Color fundus photograph. 45° FOV
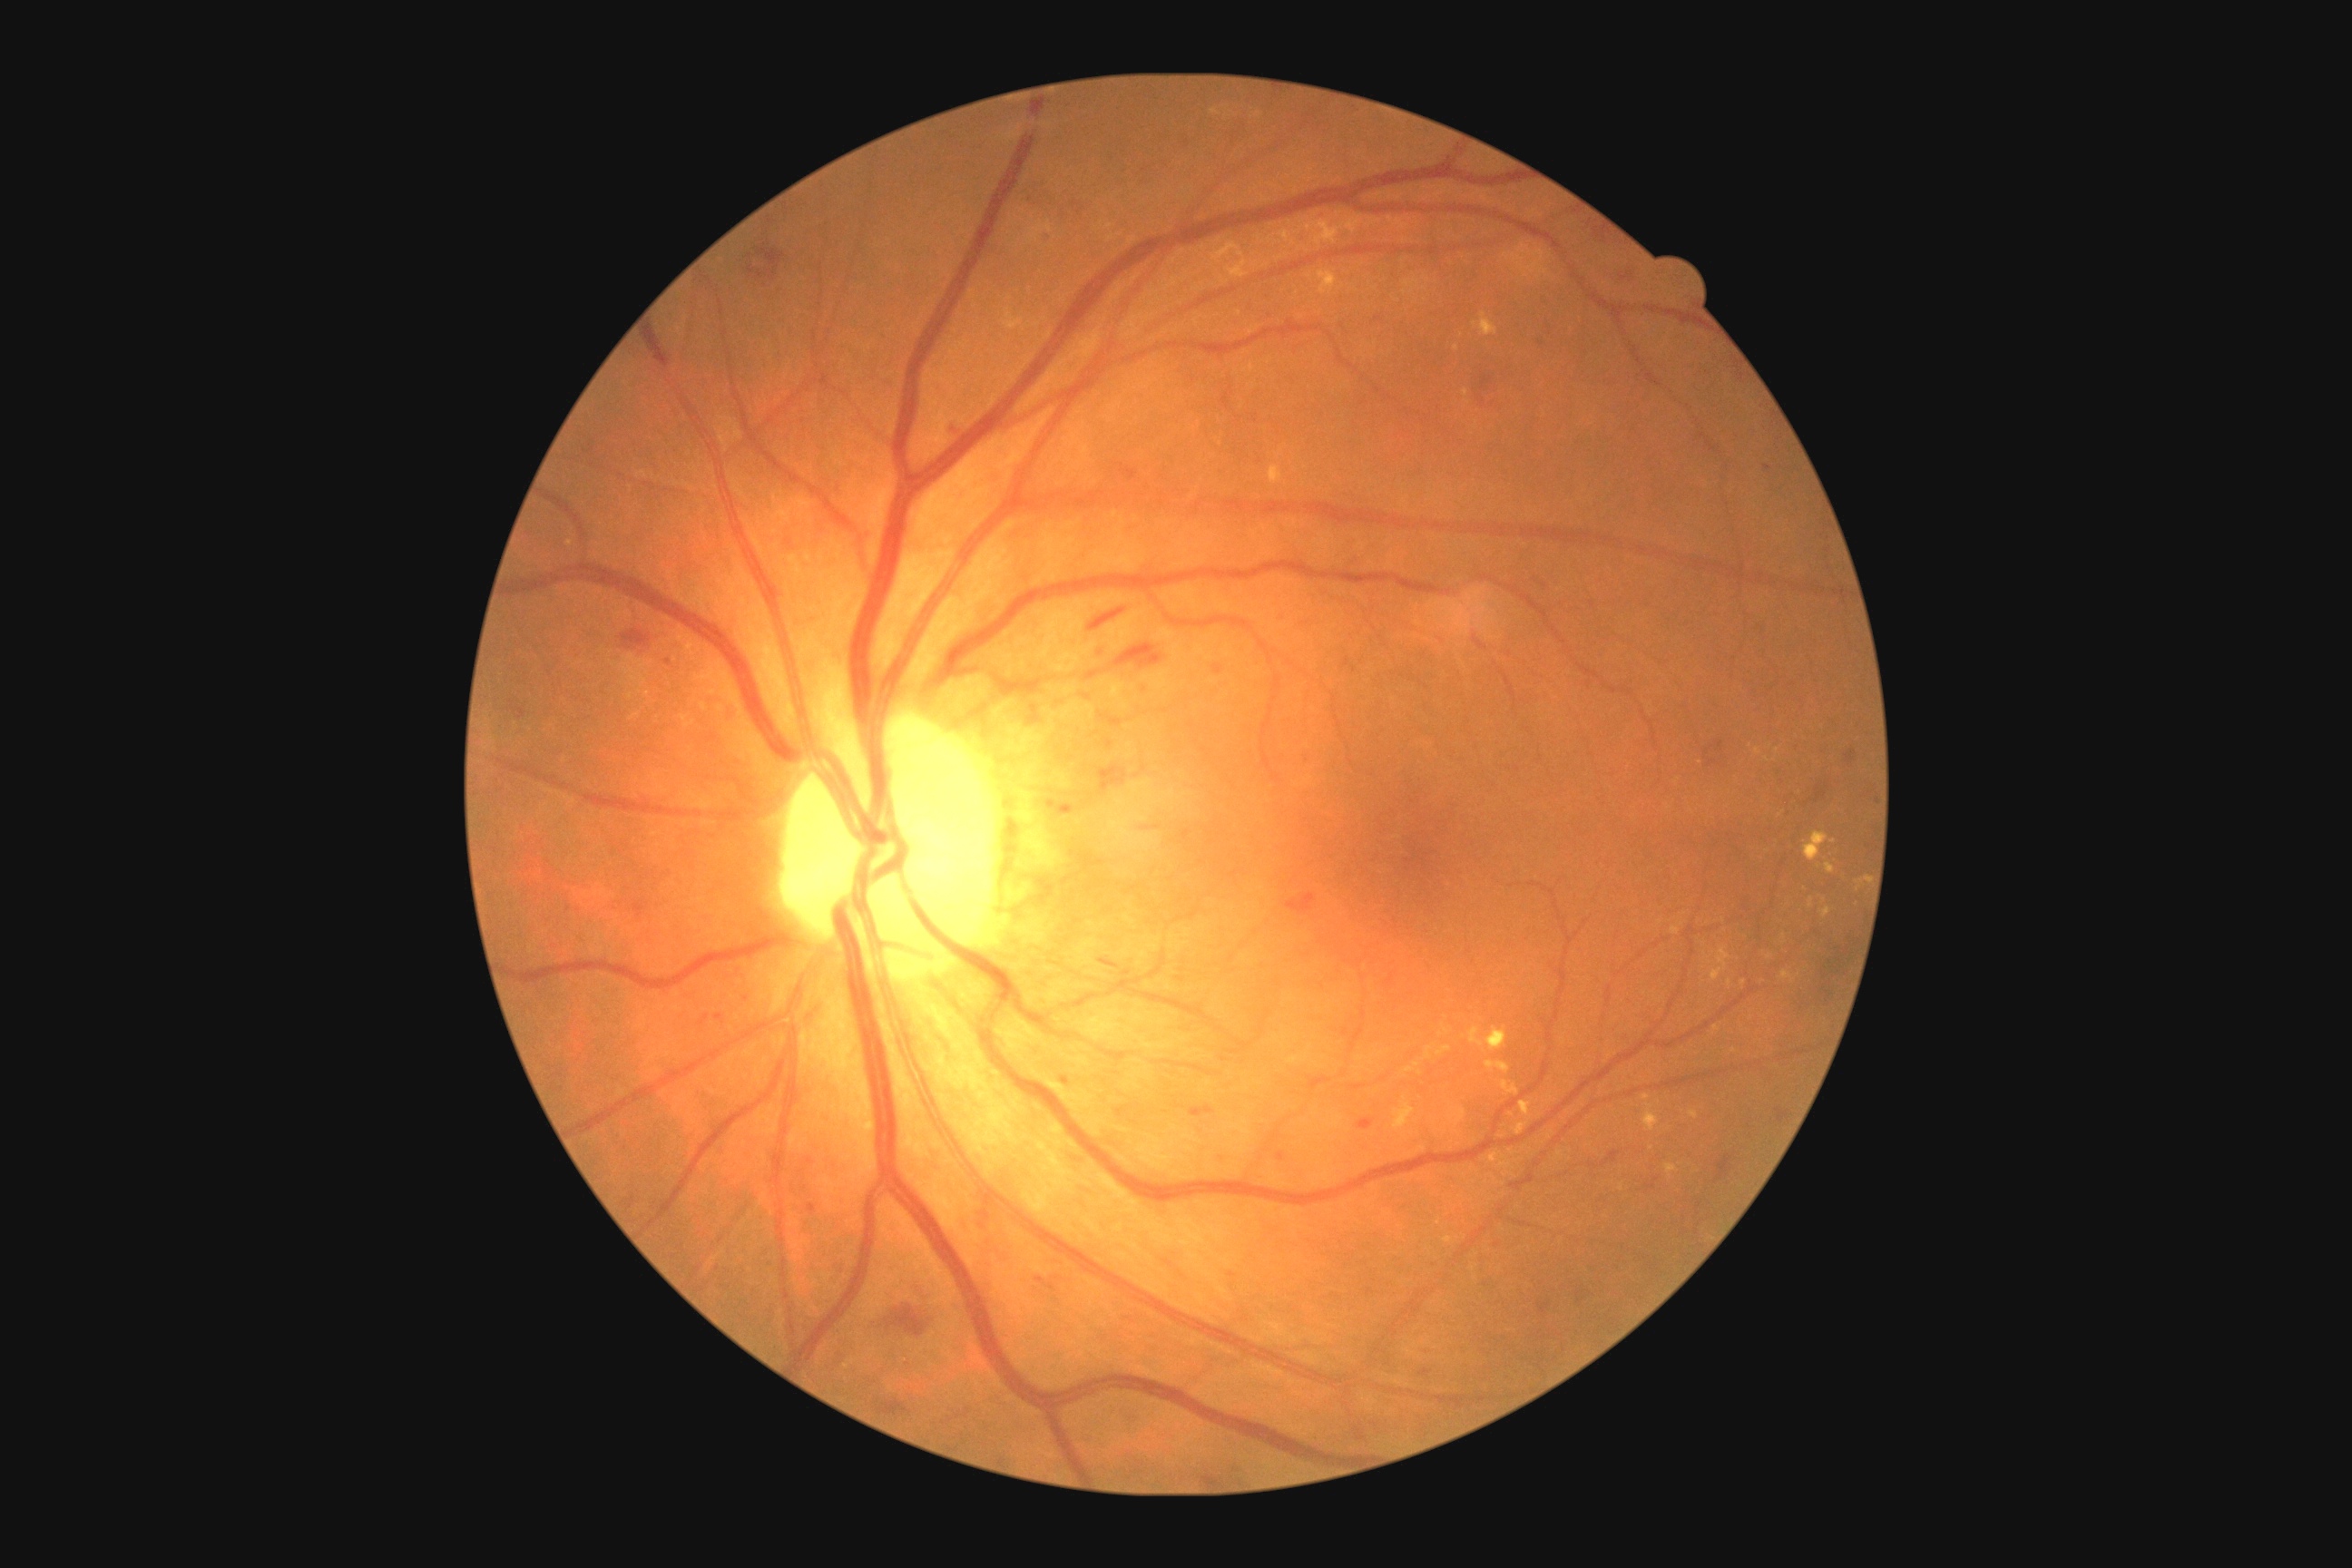 DR: moderate non-proliferative diabetic retinopathy (grade 2) — more than just microaneurysms but less than severe NPDR
Selected lesions:
* HEs (continued): {"left": 877, "top": 1400, "right": 906, "bottom": 1416}, {"left": 1422, "top": 1369, "right": 1431, "bottom": 1377}, {"left": 758, "top": 271, "right": 767, "bottom": 280}, {"left": 1182, "top": 137, "right": 1197, "bottom": 153}, {"left": 1300, "top": 754, "right": 1311, "bottom": 765}, {"left": 1122, "top": 821, "right": 1170, "bottom": 836}, {"left": 1279, "top": 1153, "right": 1284, "bottom": 1161}, {"left": 758, "top": 248, "right": 787, "bottom": 280}, {"left": 1718, "top": 1157, "right": 1732, "bottom": 1179}, {"left": 1358, "top": 1119, "right": 1373, "bottom": 1130}, {"left": 1778, "top": 1110, "right": 1788, "bottom": 1122}, {"left": 1534, "top": 337, "right": 1547, "bottom": 351}
* Smaller HEs around pt(810, 1162), pt(1052, 1288), pt(1712, 763)